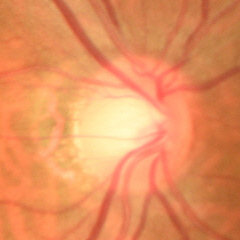

Glaucomatous changes are present.
Early glaucomatous optic neuropathy.